Remidio Fundus on Phone (FOP) camera.
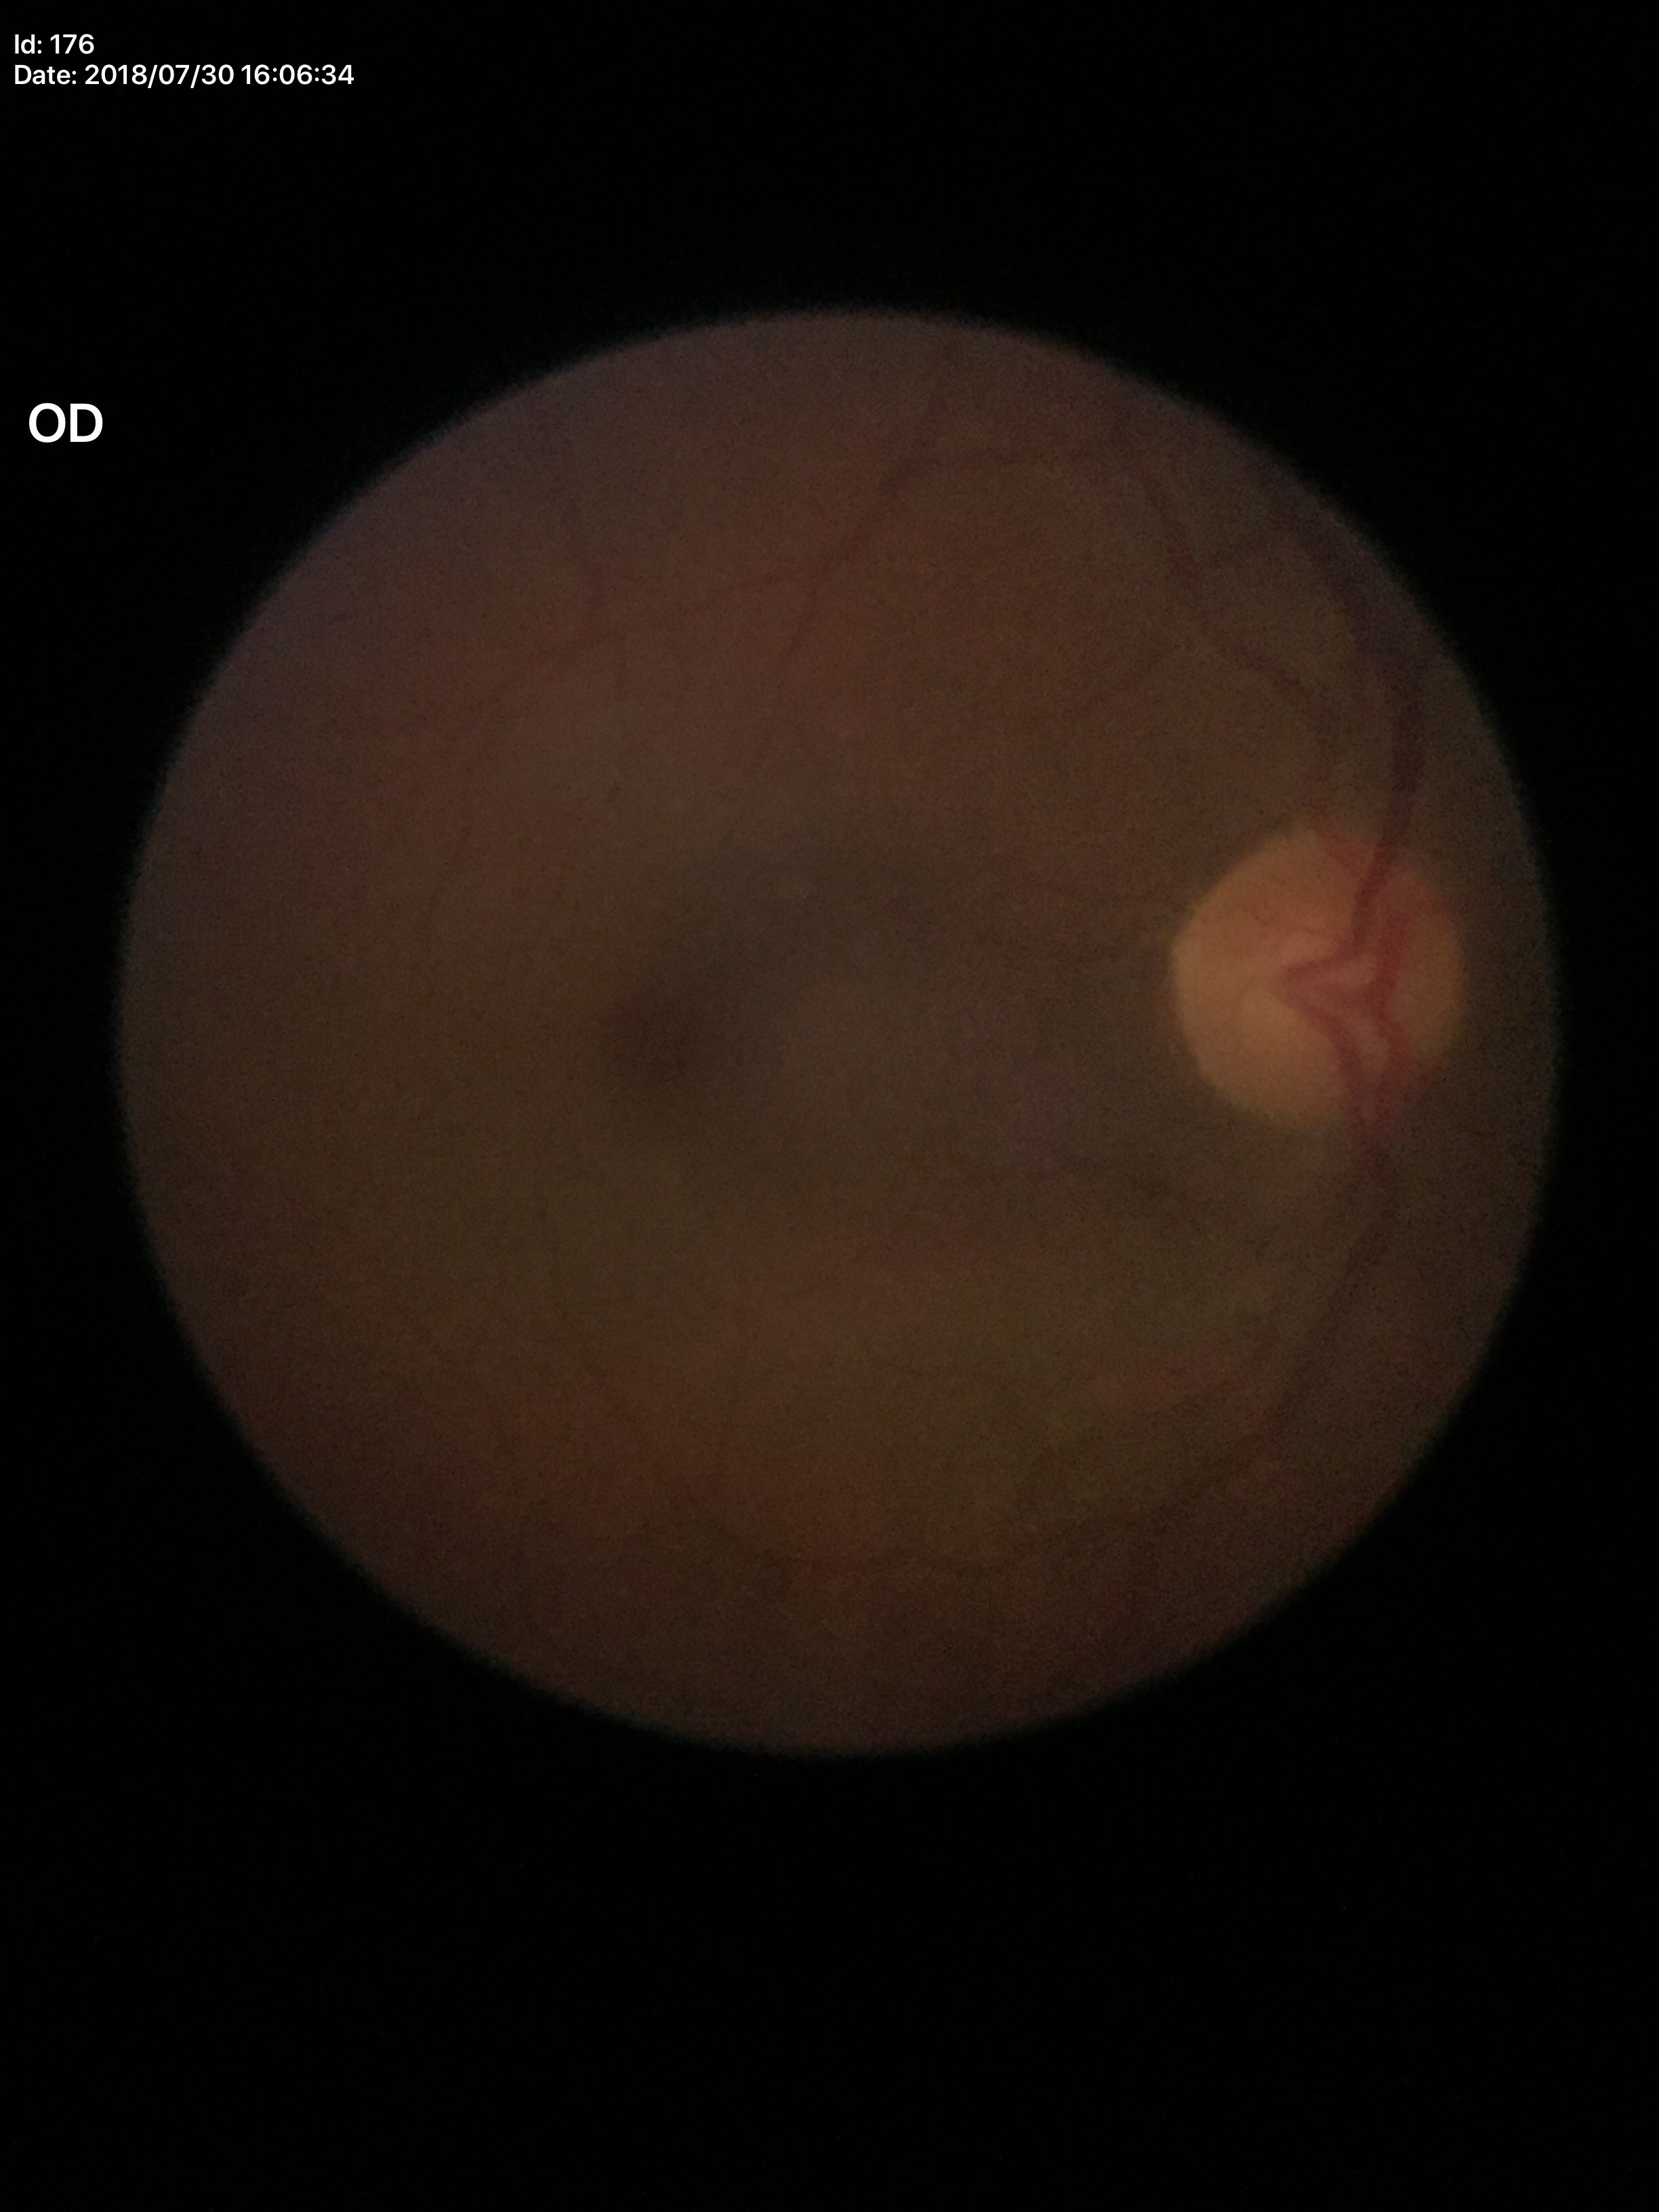
glaucoma_decision: not suspect (unanimous normal call)
hcdr: 0.53
vcdr: 0.50